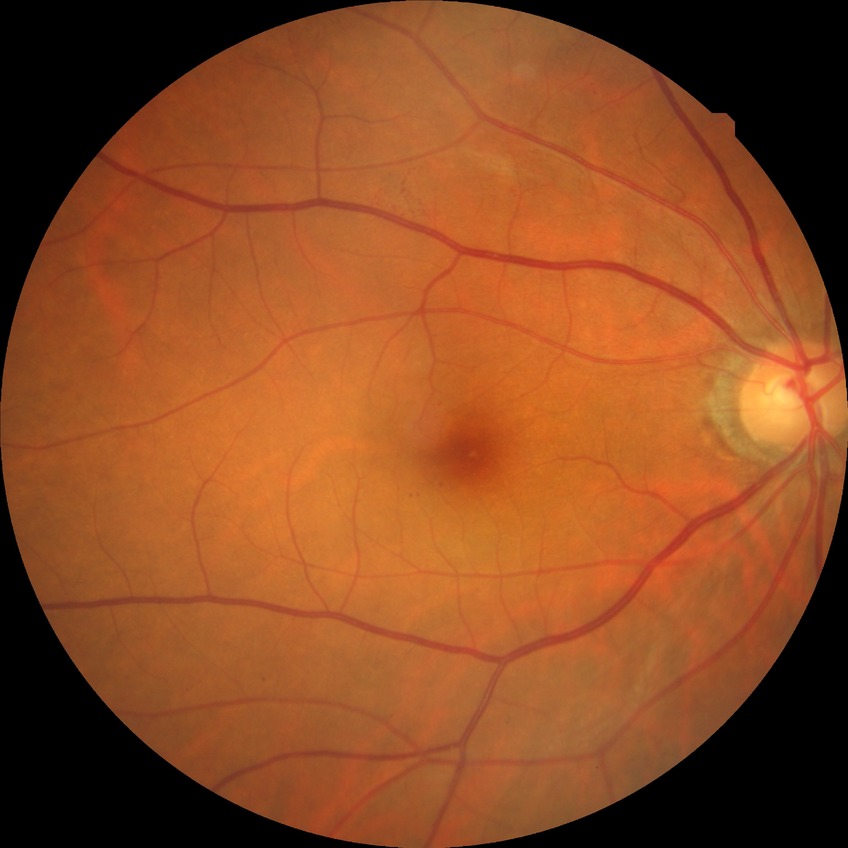 Diabetic retinopathy severity: no diabetic retinopathy.